2352x1568 · 45° field of view:
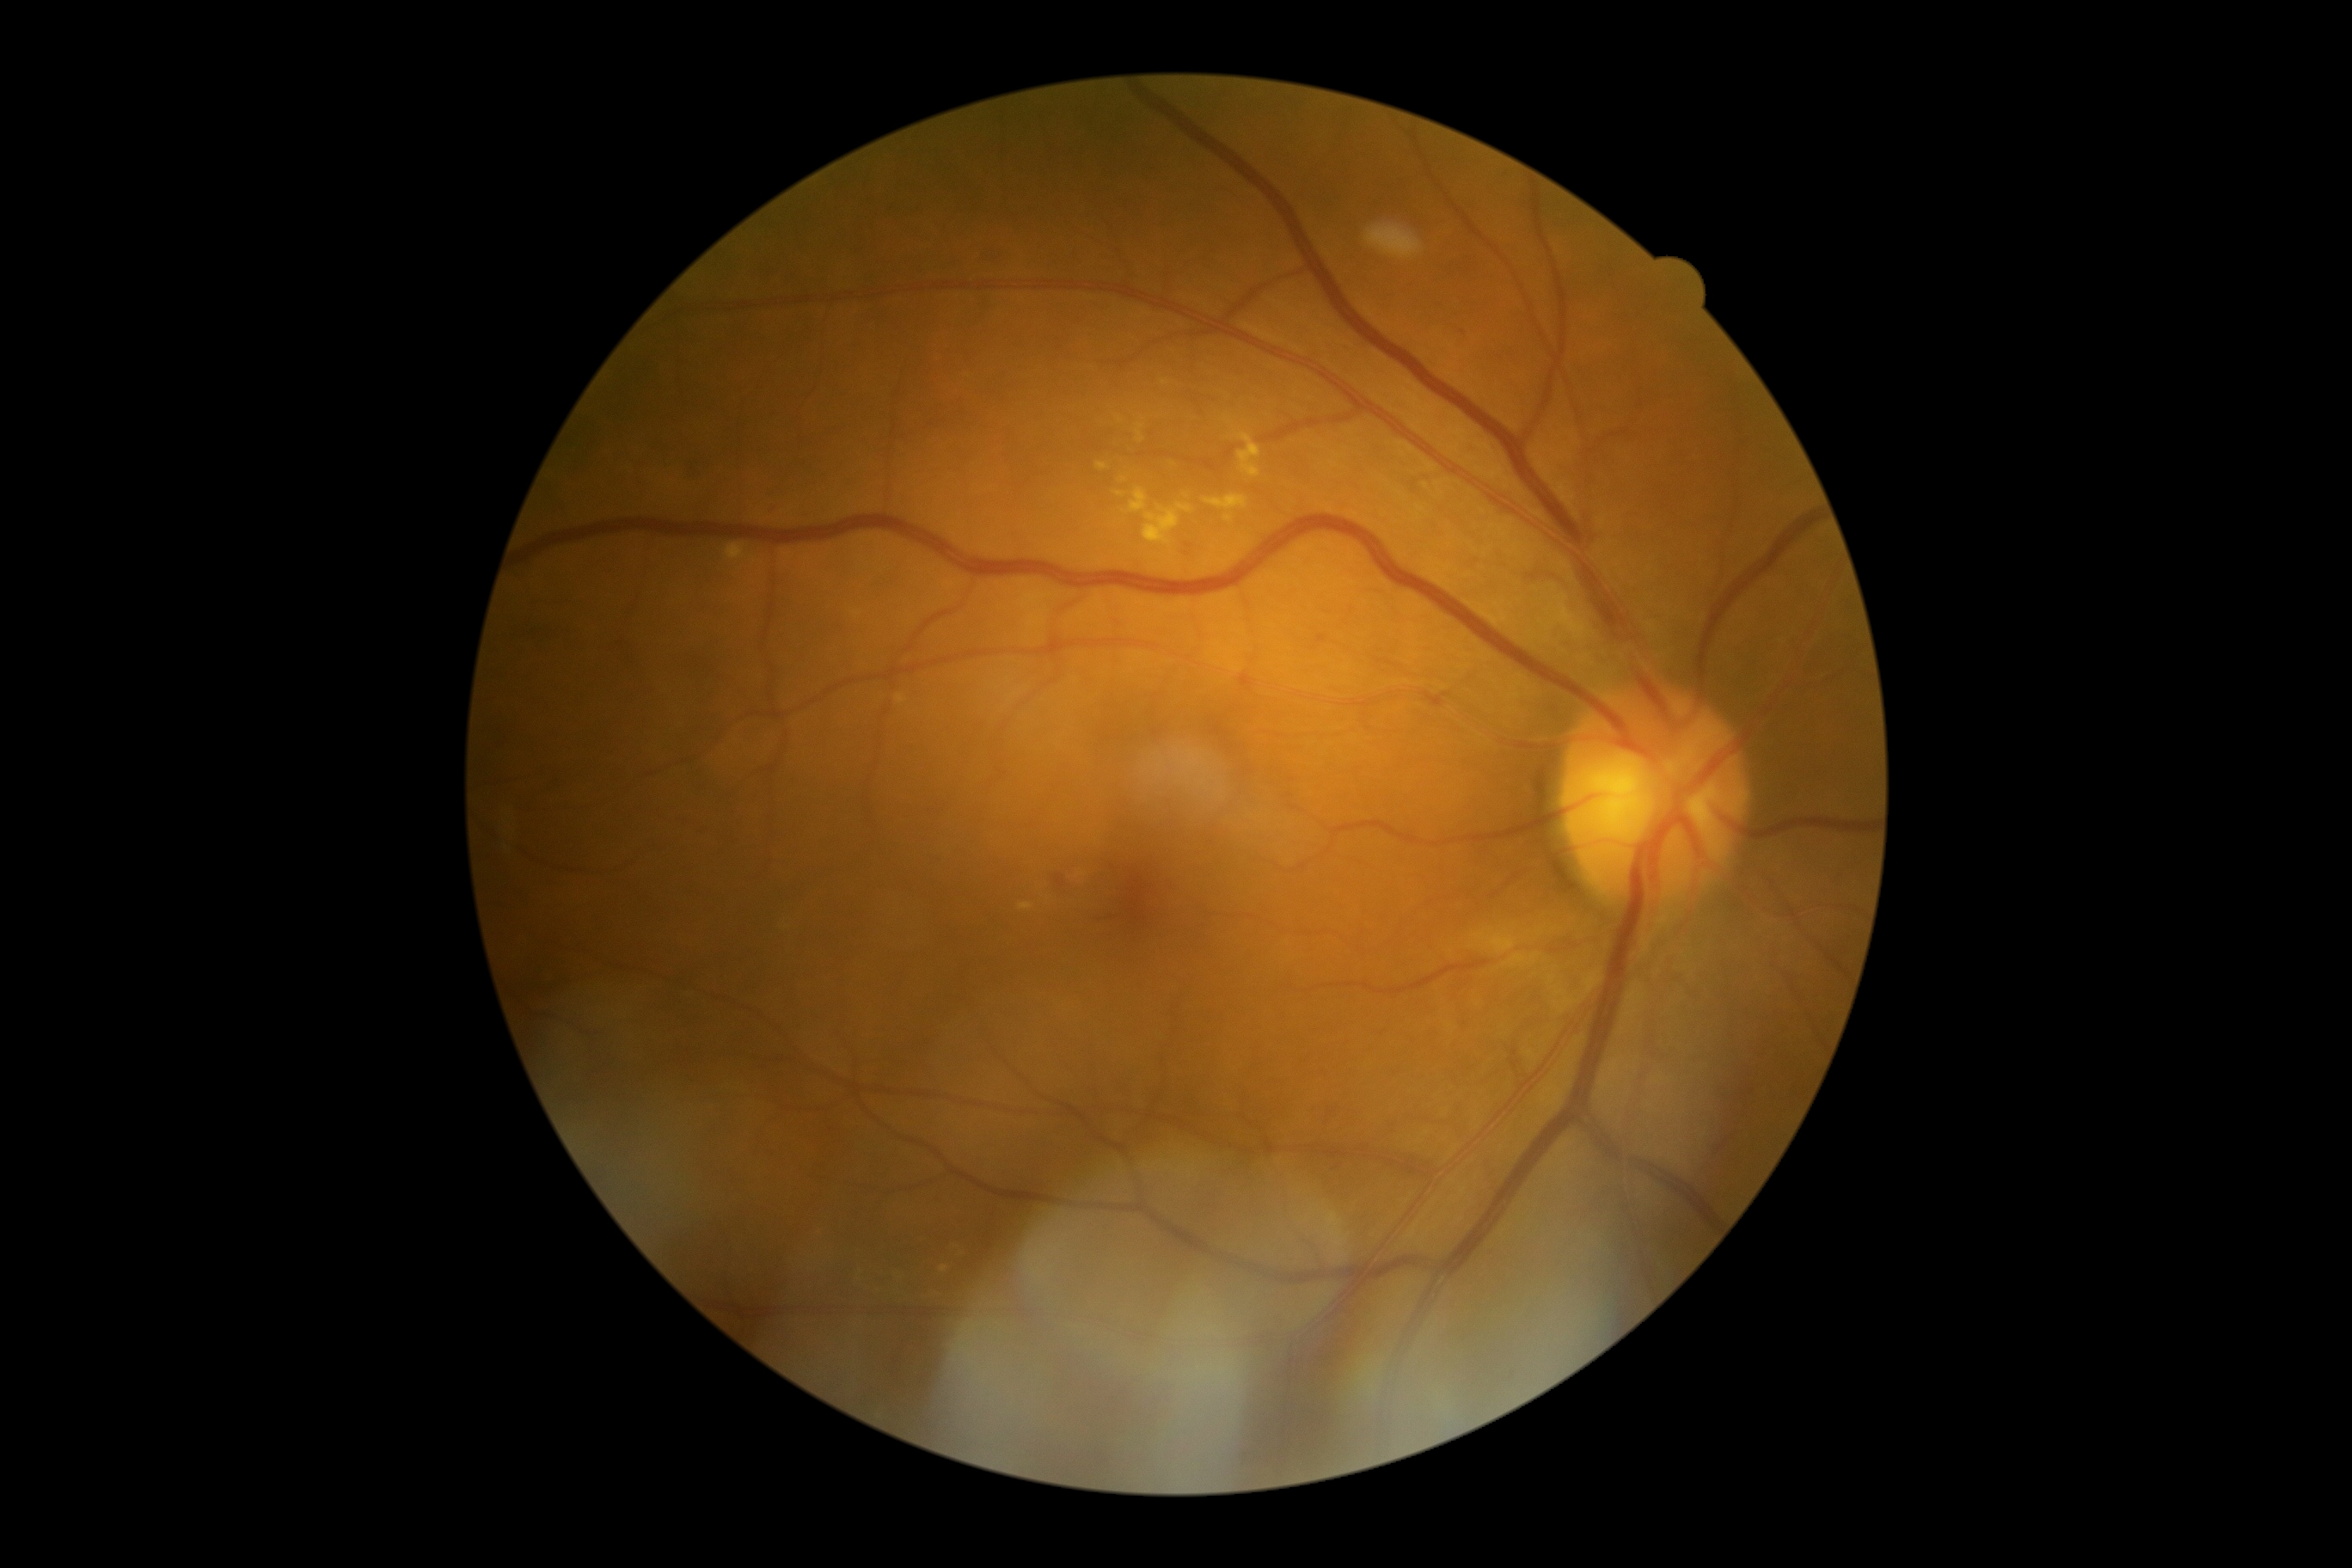 Diabetic retinopathy grade: 2 (moderate NPDR).